Color fundus photograph:
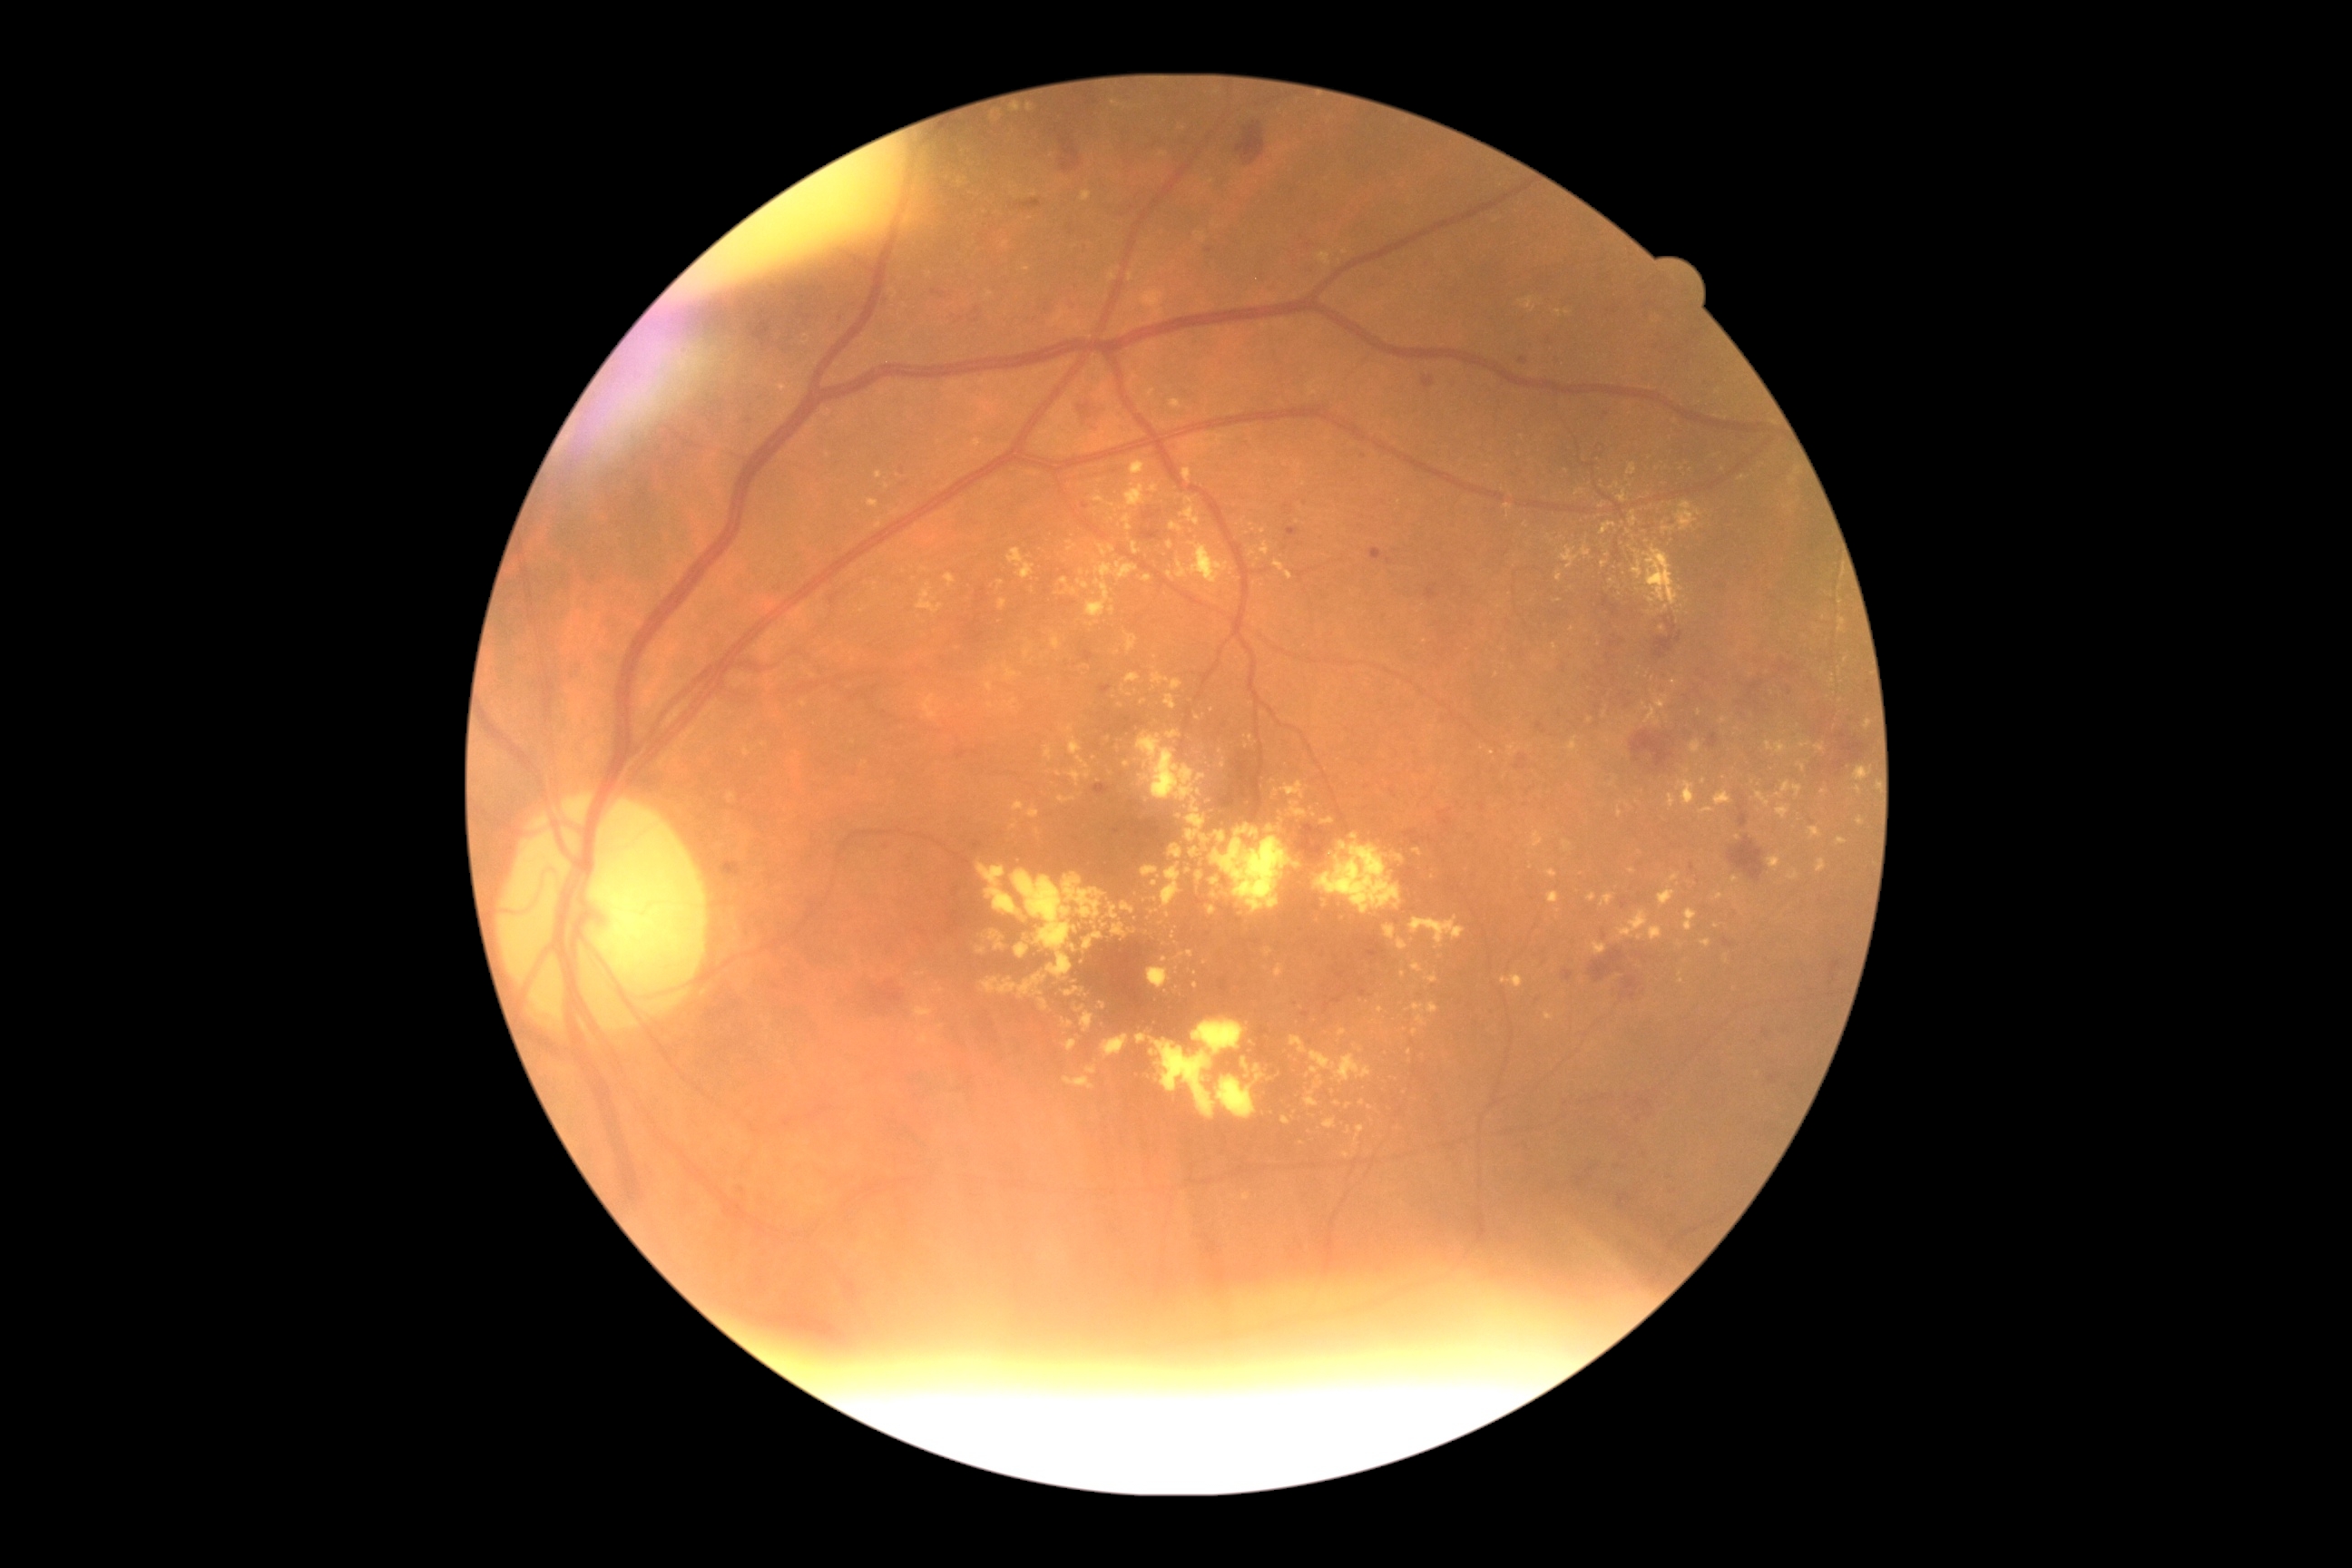
{"partial": true, "dr_grade": 2, "dr_grade_name": "moderate NPDR", "lesions": {"ex": [[778, 384, 798, 400], [1150, 910, 1159, 914], [917, 1034, 930, 1046], [1732, 877, 1740, 885], [890, 289, 899, 299], [1137, 734, 1206, 801], [1700, 807, 1714, 814], [1037, 830, 1041, 838], [1545, 1014, 1554, 1021], [1101, 1034, 1128, 1059], [1242, 1059, 1250, 1070], [1182, 469, 1191, 484], [1141, 867, 1159, 879], [945, 172, 956, 184]], "ex_small_approx": [[895, 512], [1315, 816], [1403, 974], [1177, 971], [1064, 582]]}}